Retinal fundus photograph, no pharmacologic dilation, 848 x 848 pixels, NIDEK AFC-230 fundus camera — 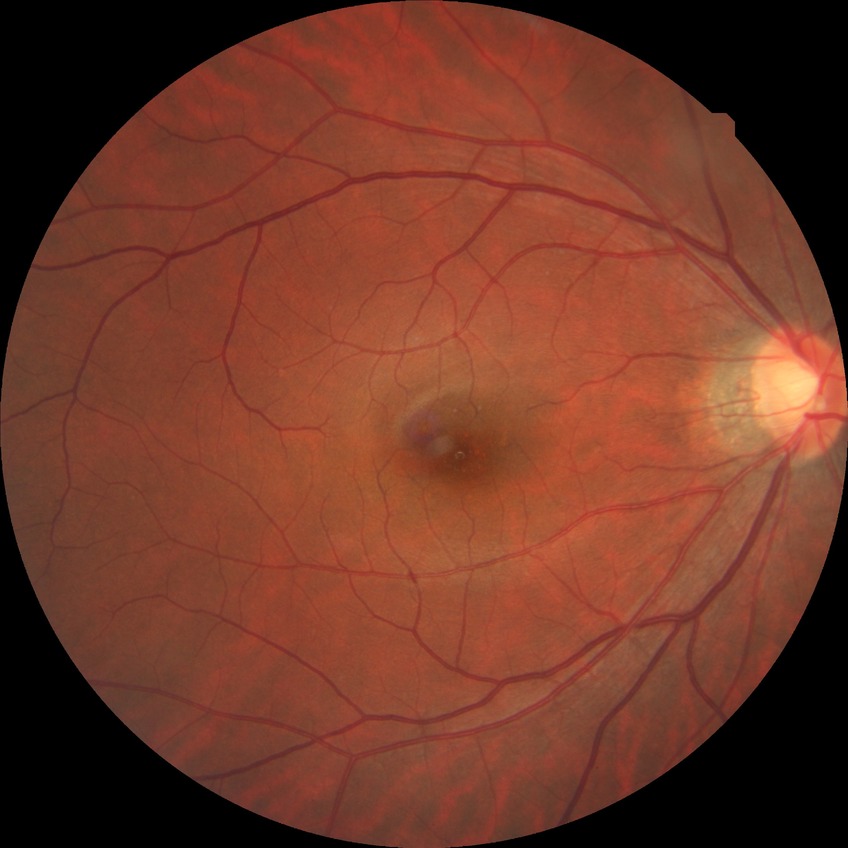
Diabetic retinopathy (DR): NDR (no diabetic retinopathy).